848x848px · modified Davis grading:
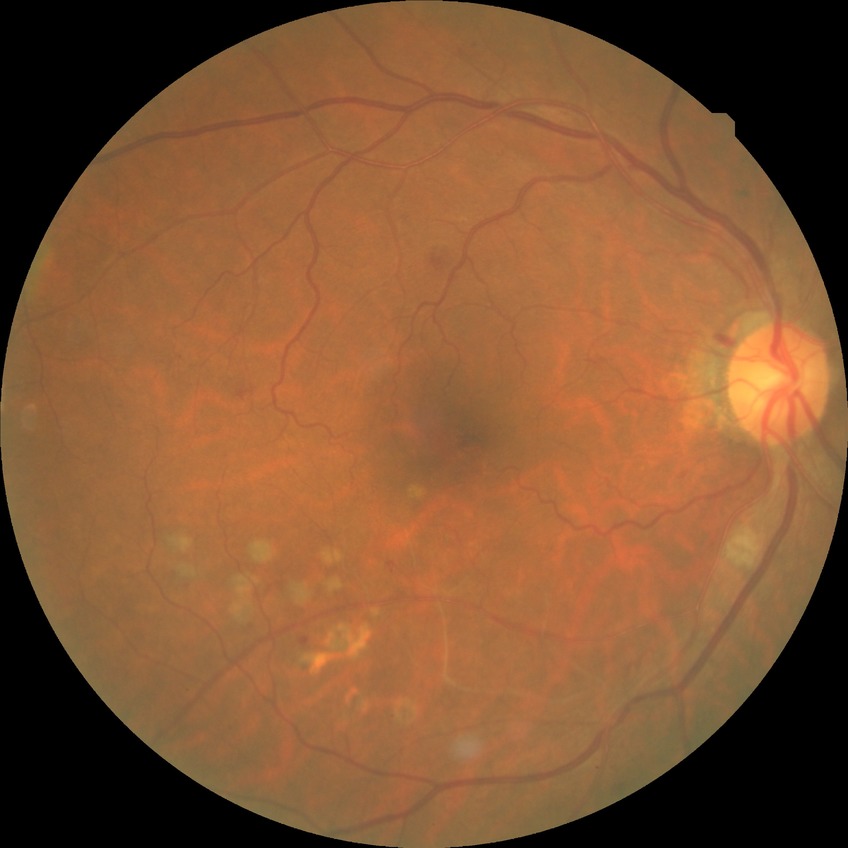

Diabetic retinopathy stage is simple diabetic retinopathy.